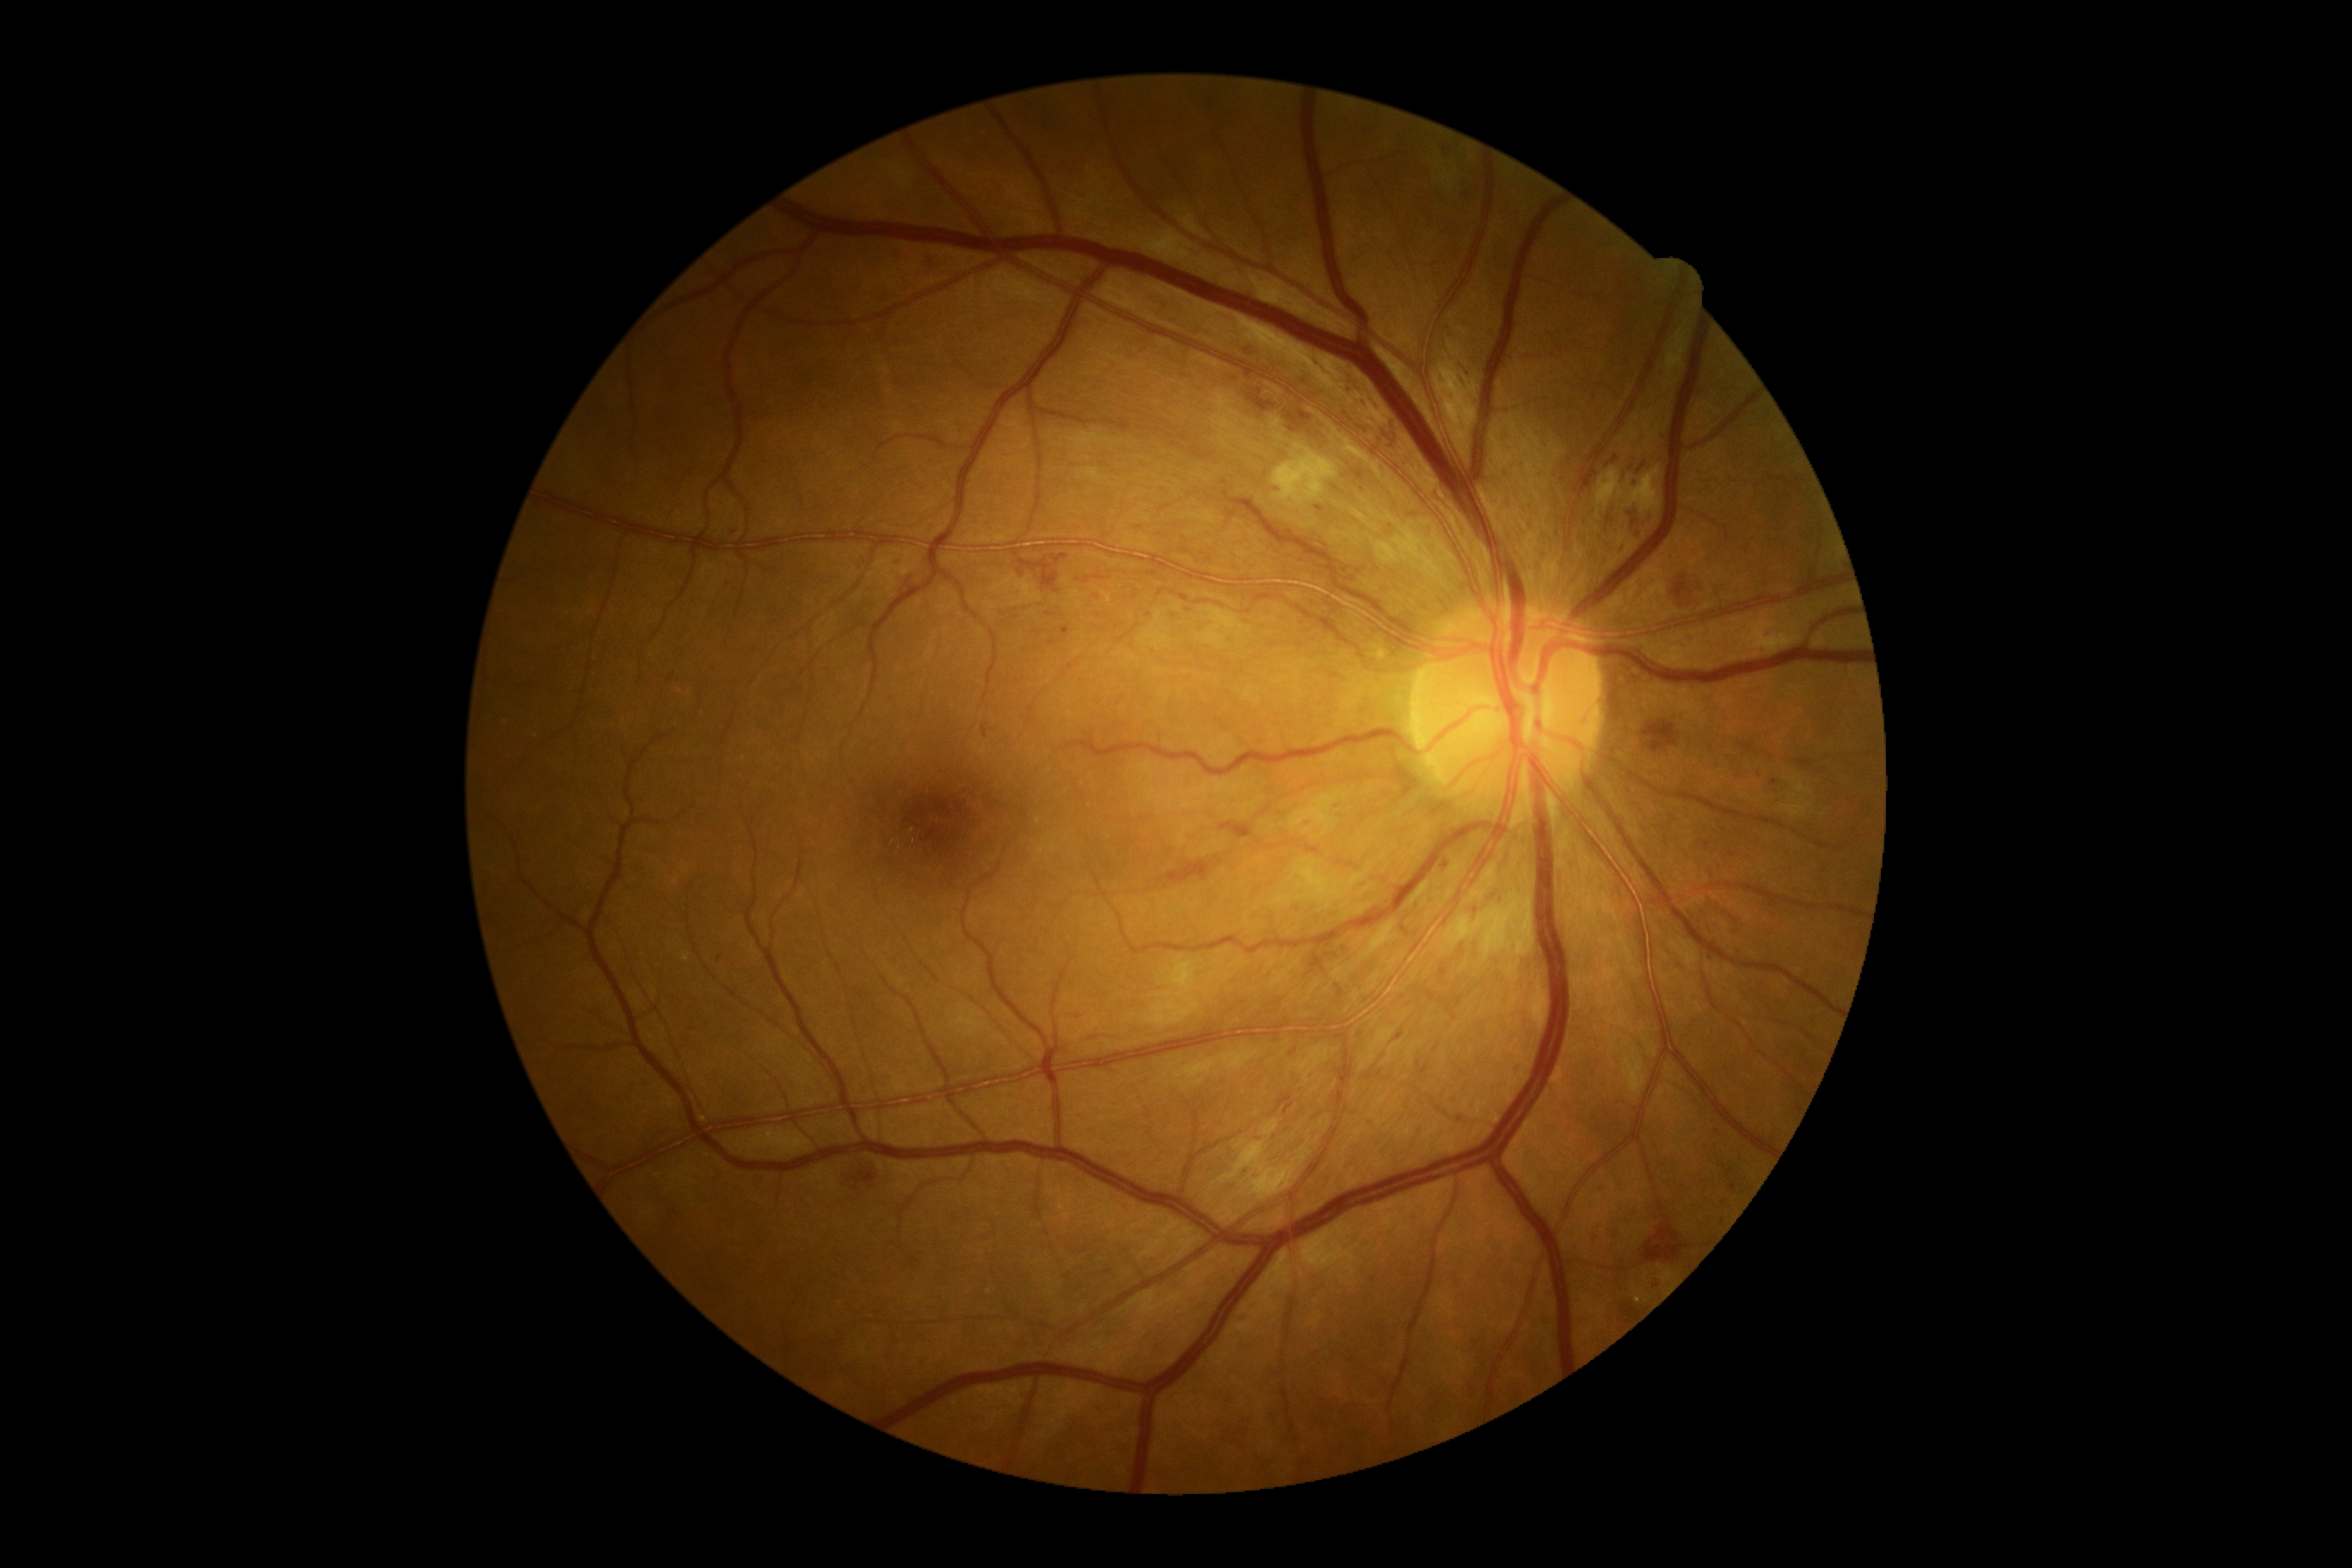 DR grade: 3.